Captured on a Remidio Fundus on Phone (FOP) camera: 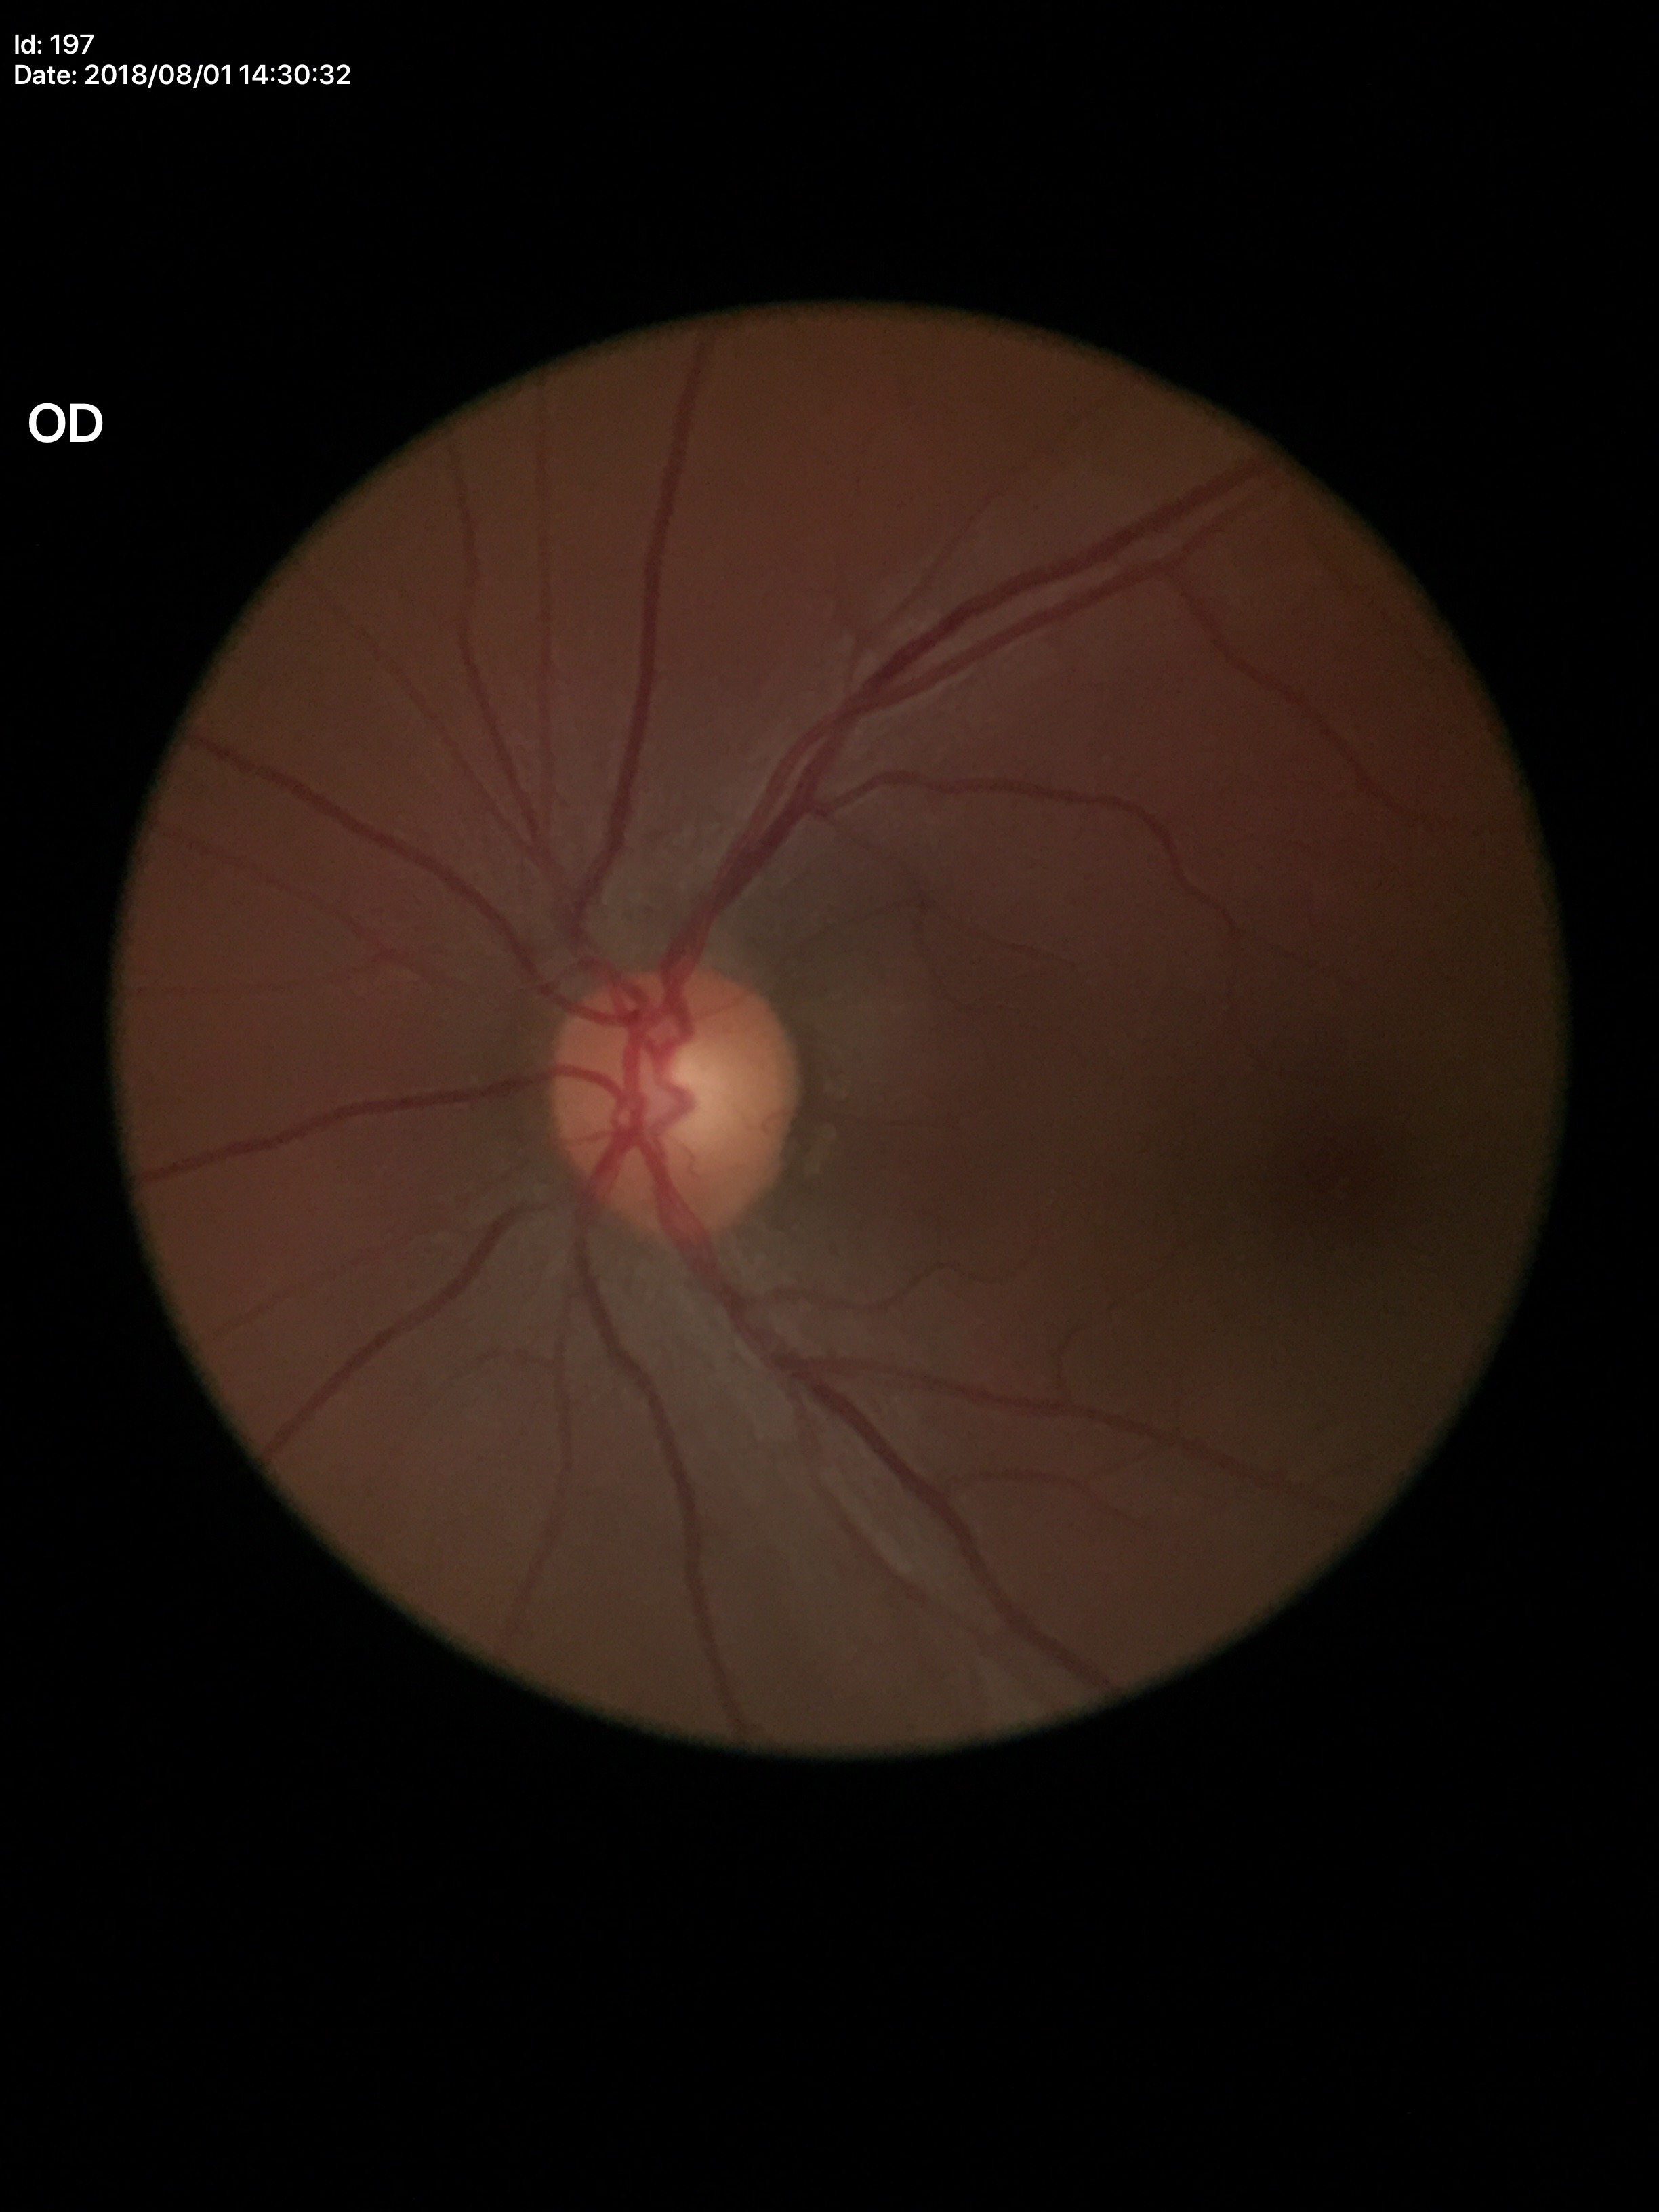

No glaucomatous findings (5/5 ophthalmologists in agreement). VCDR: 0.52. ACDR: 0.28.